848x848px. Posterior pole color fundus photograph. Nonmydriatic. NIDEK AFC-230
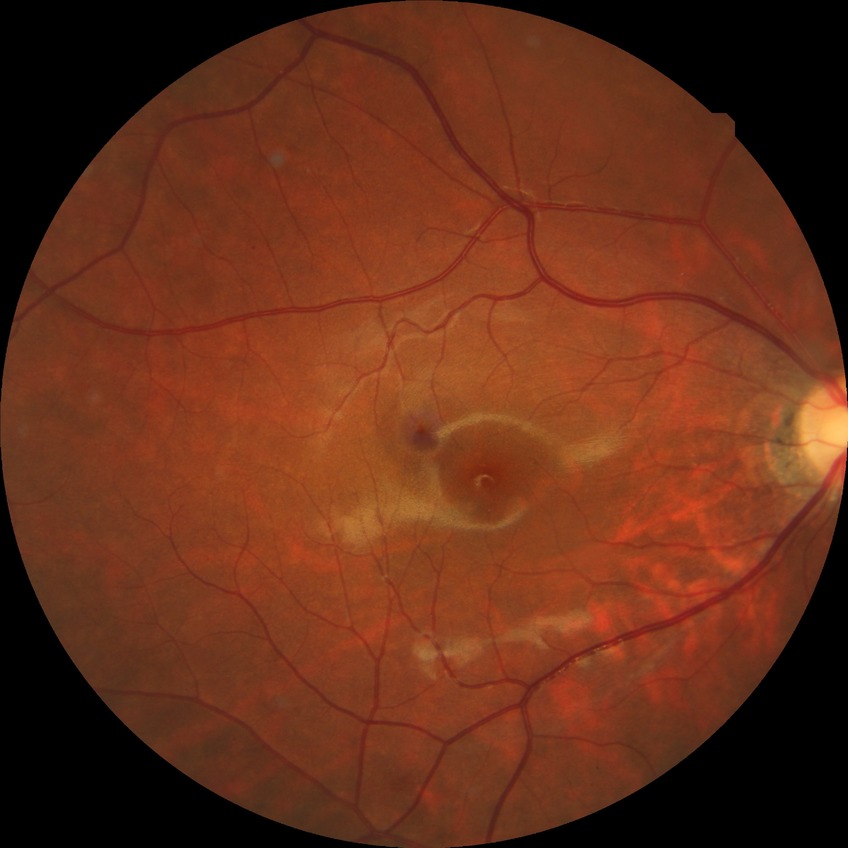

Retinopathy stage: no diabetic retinopathy.